1624x1232, color fundus photograph, 45° field of view.
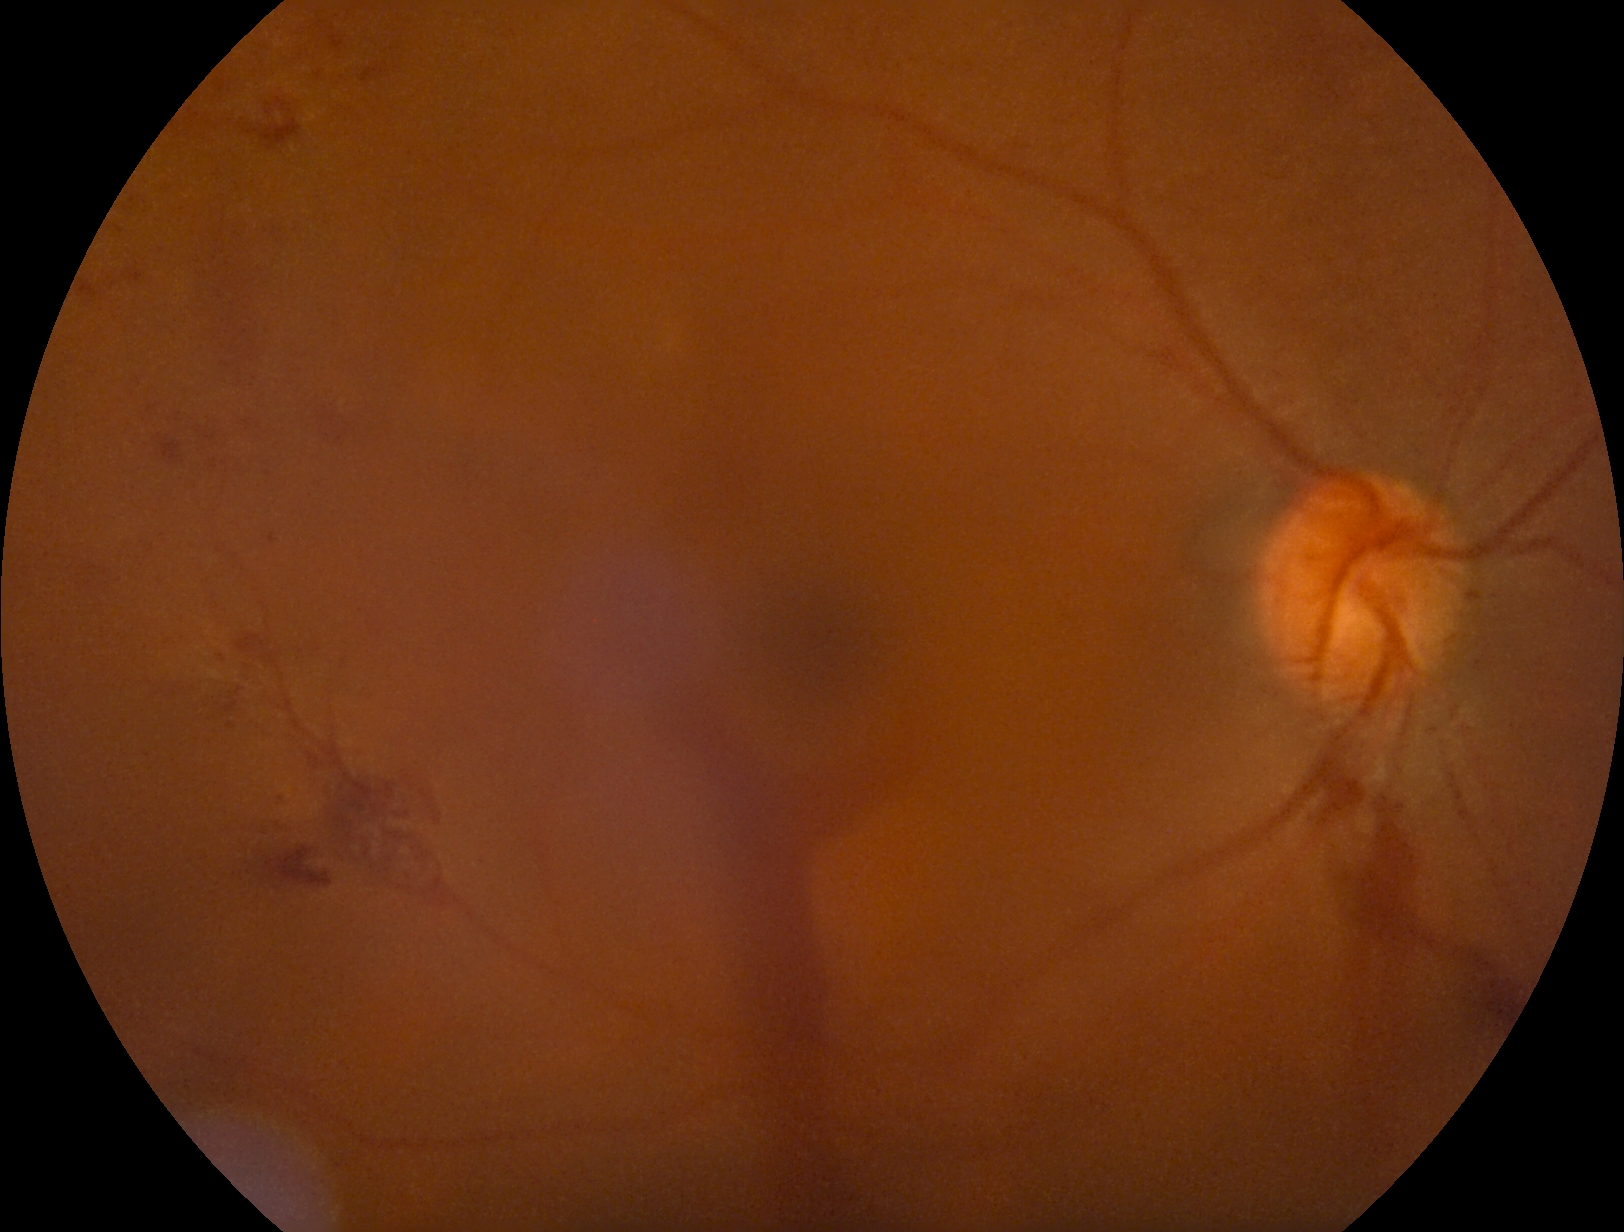 Retinopathy grade: PDR (4).